Wide-field fundus photograph from neonatal ROP screening · 1240x1240px.
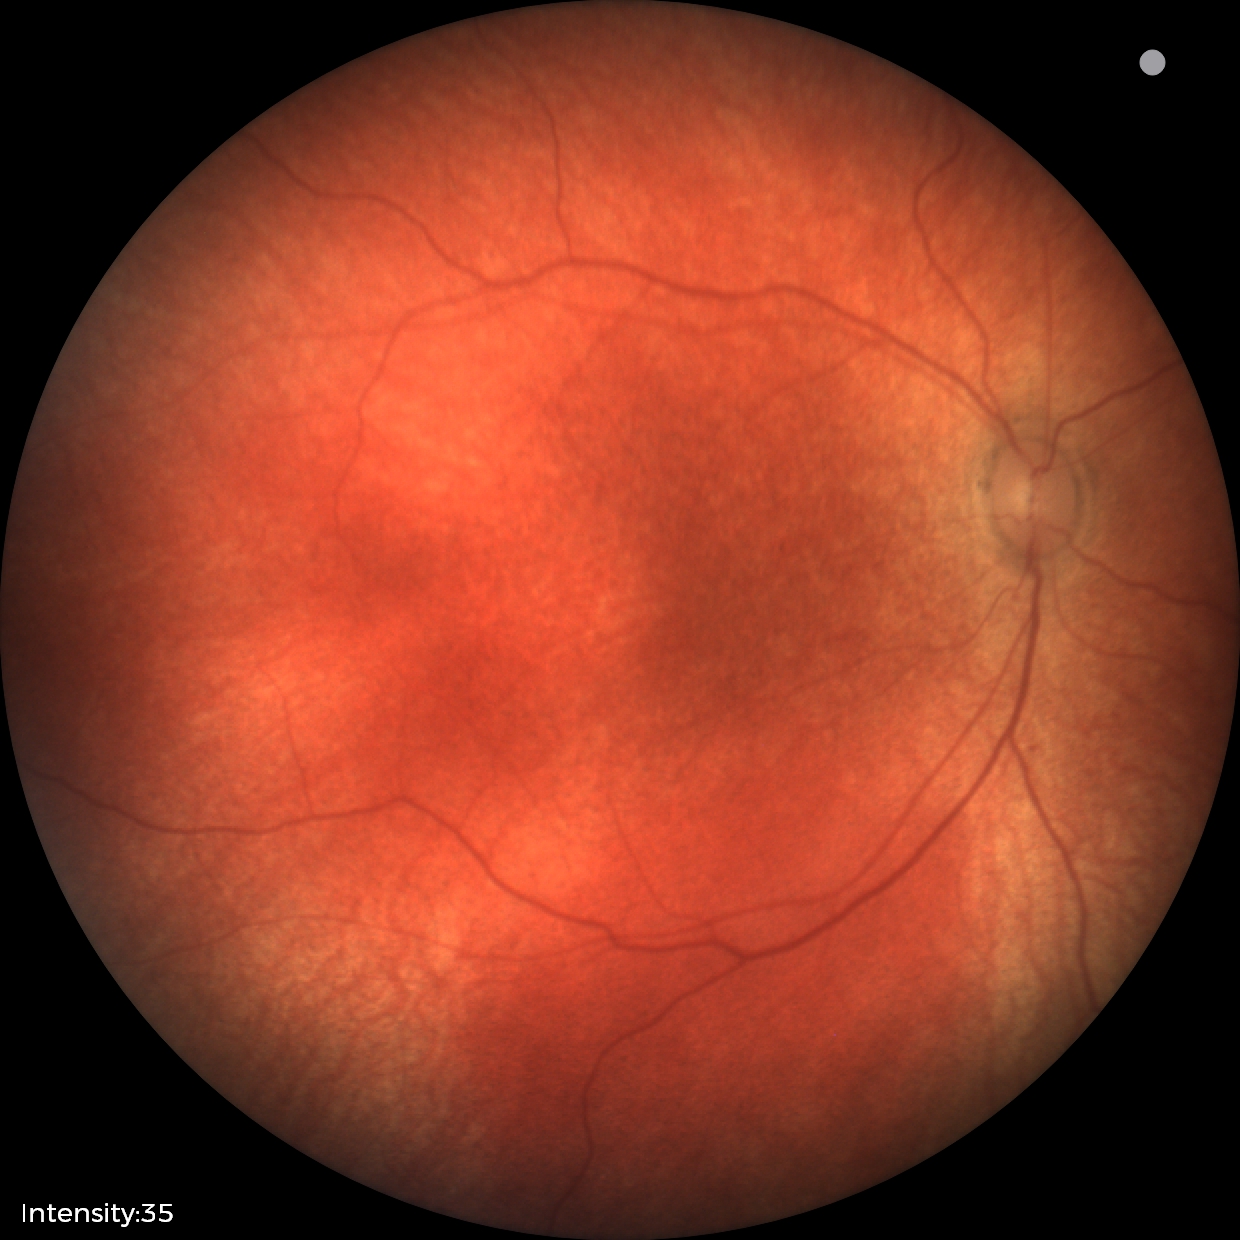
Screening examination with no abnormal retinal findings.